Ultra-widefield fundus mosaic — 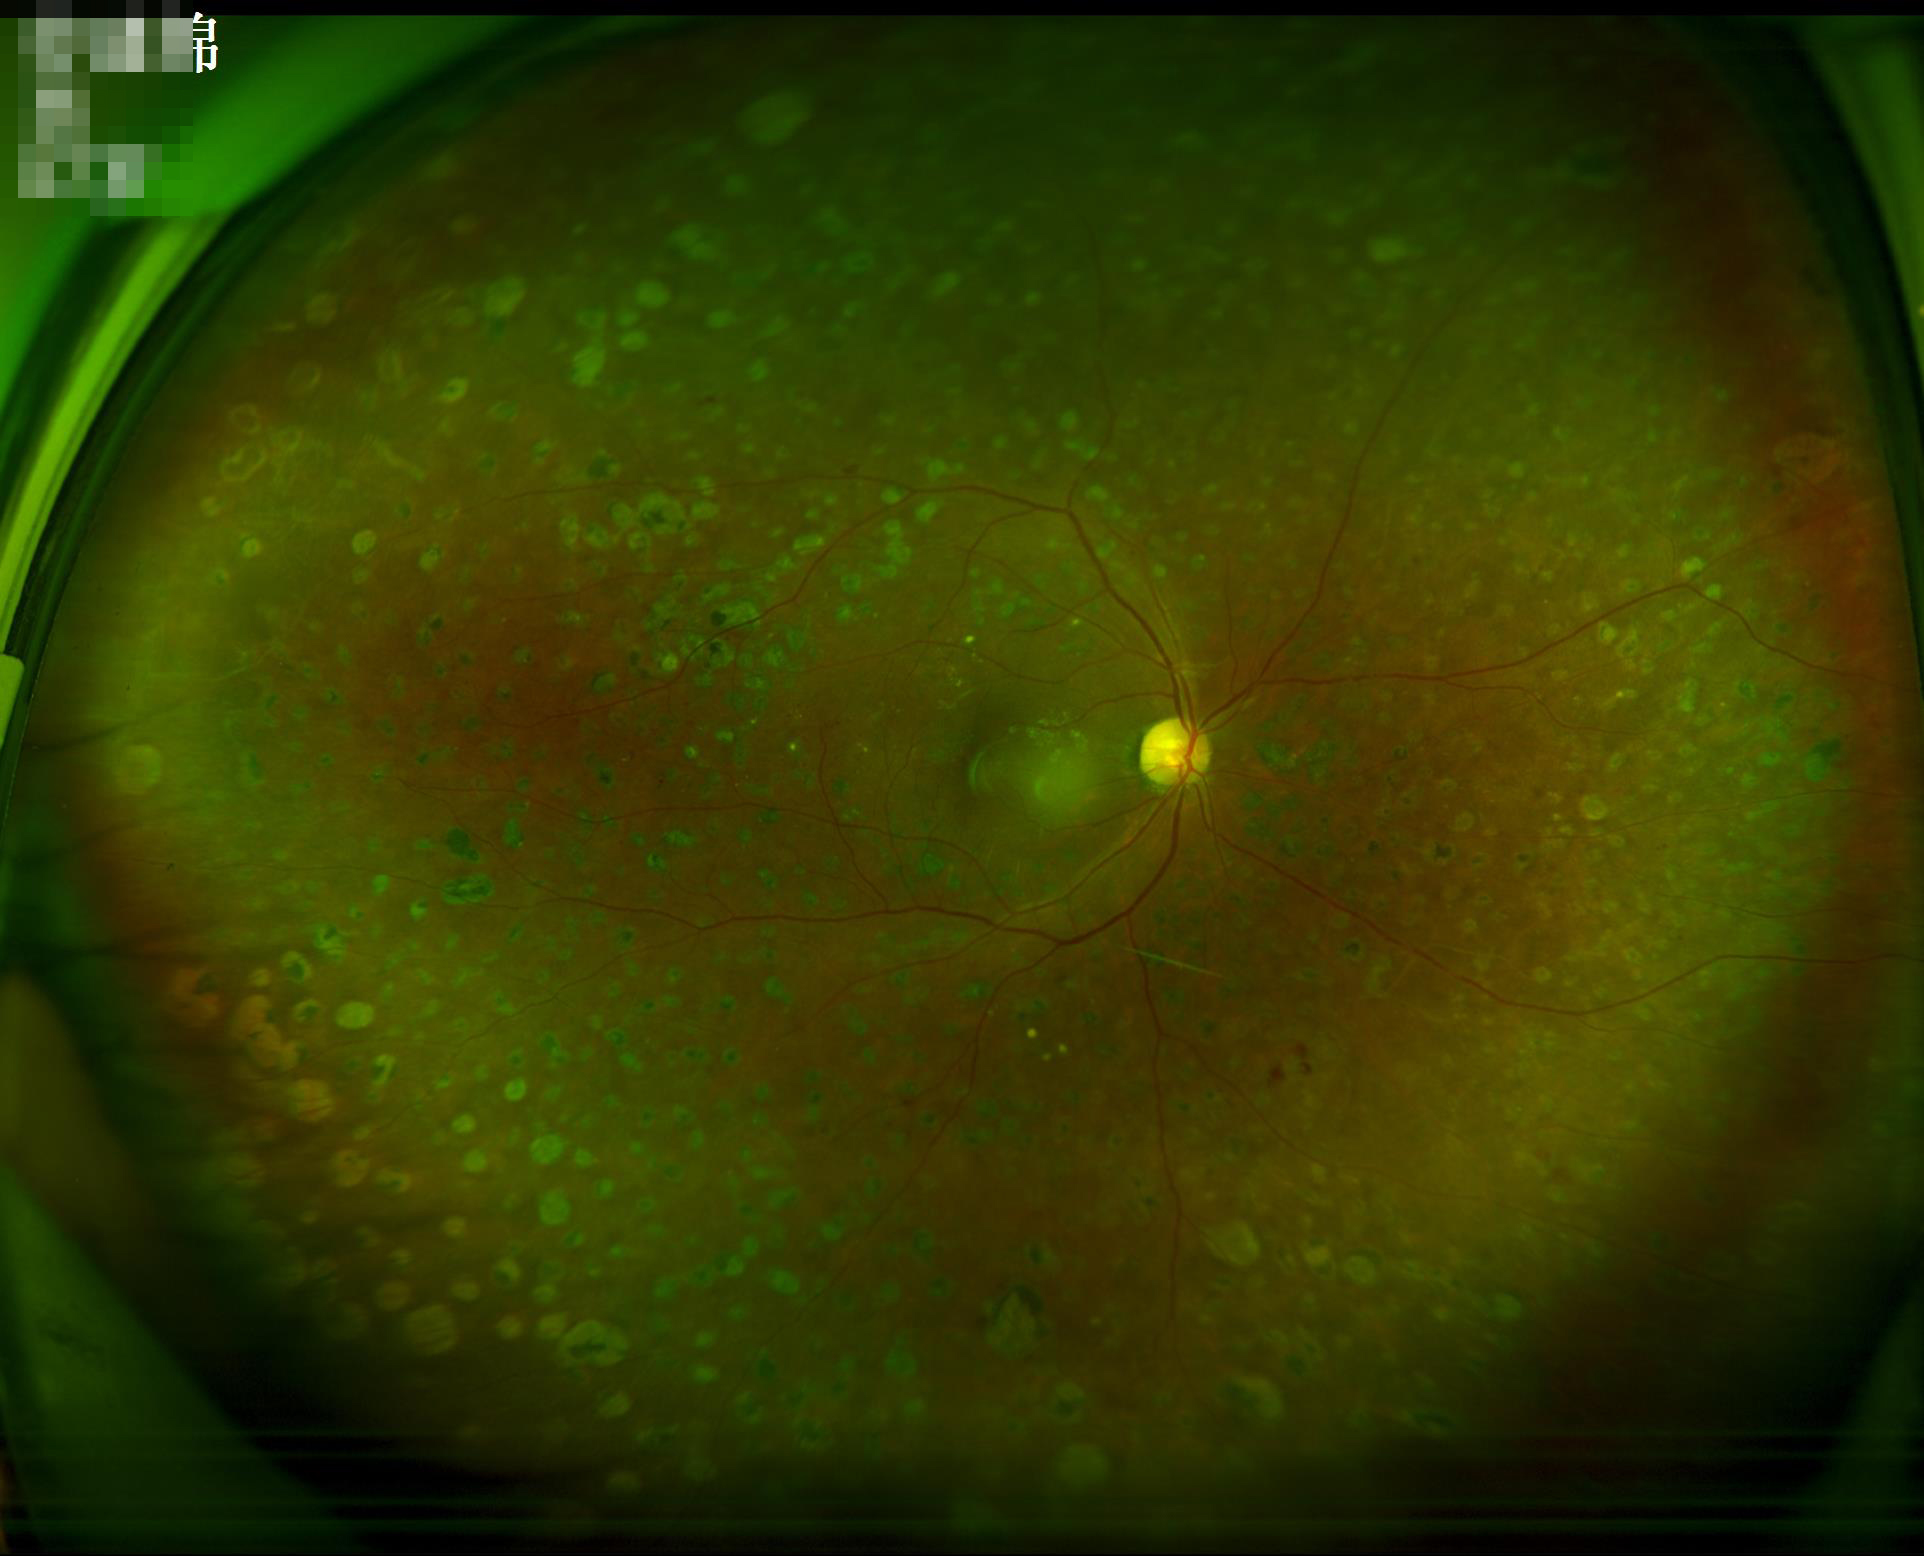 Overall = good and suitable for diagnostic use | Illumination = good illumination and color balance | Sharpness = optic disc, vessels, and background in focus | Contrast = good dynamic range.